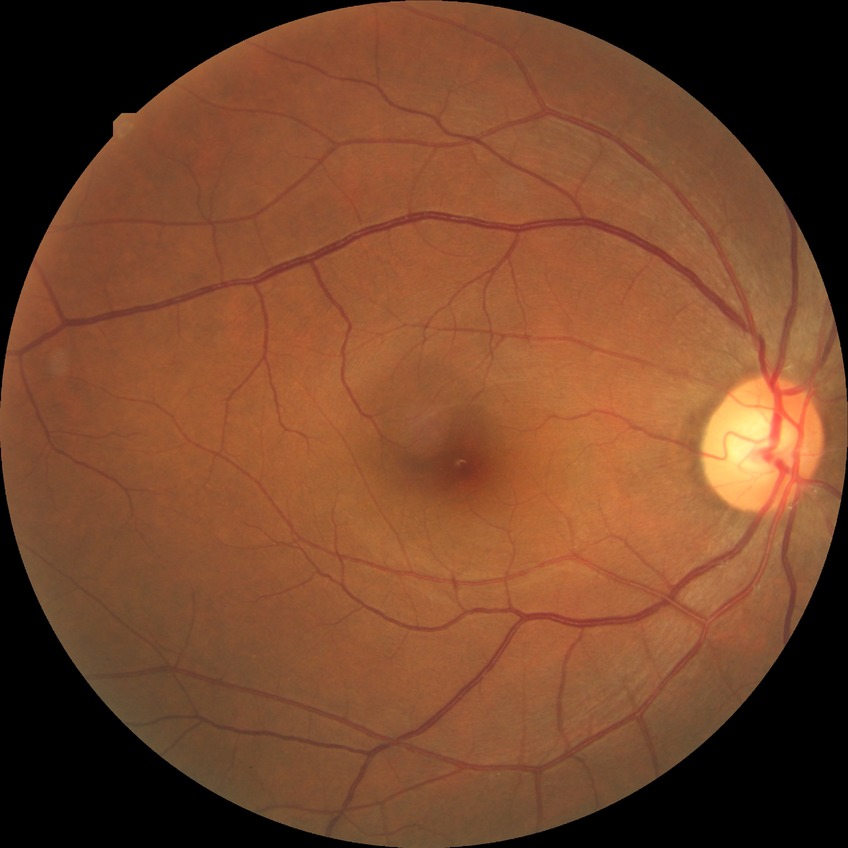
diabetic retinopathy (DR) = NDR (no diabetic retinopathy).